Without pupil dilation, image size 848x848, camera: NIDEK AFC-230, 45-degree field of view
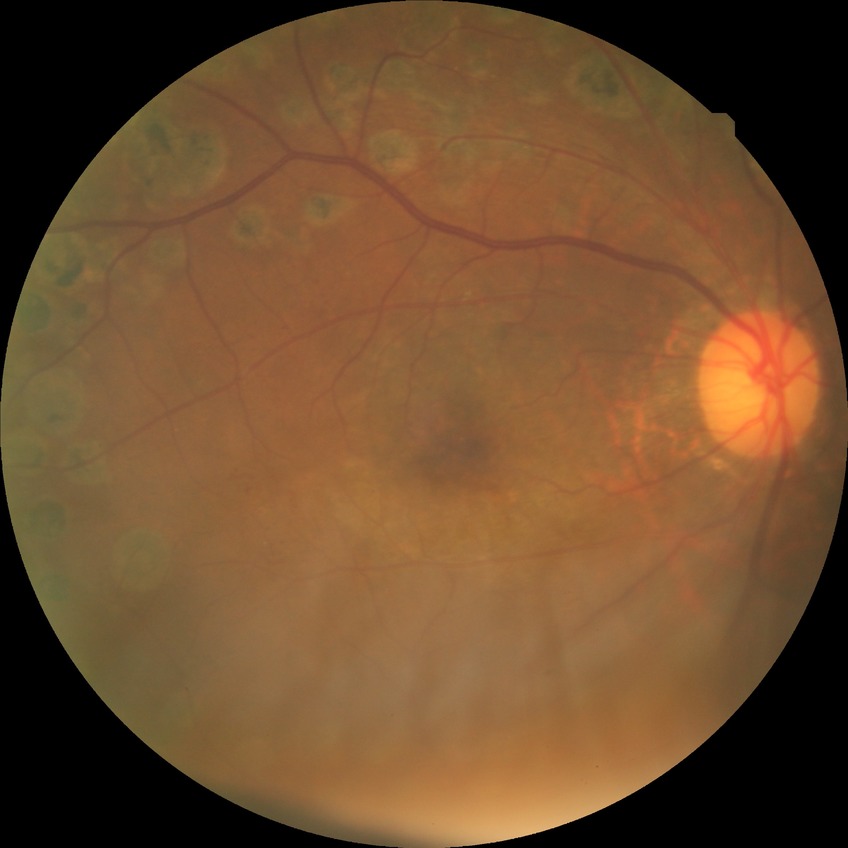

diabetic retinopathy (DR) = PDR (proliferative diabetic retinopathy).